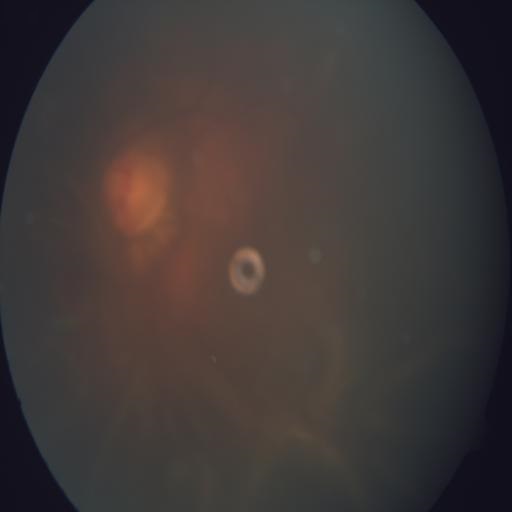

Pathology: tilted disc.